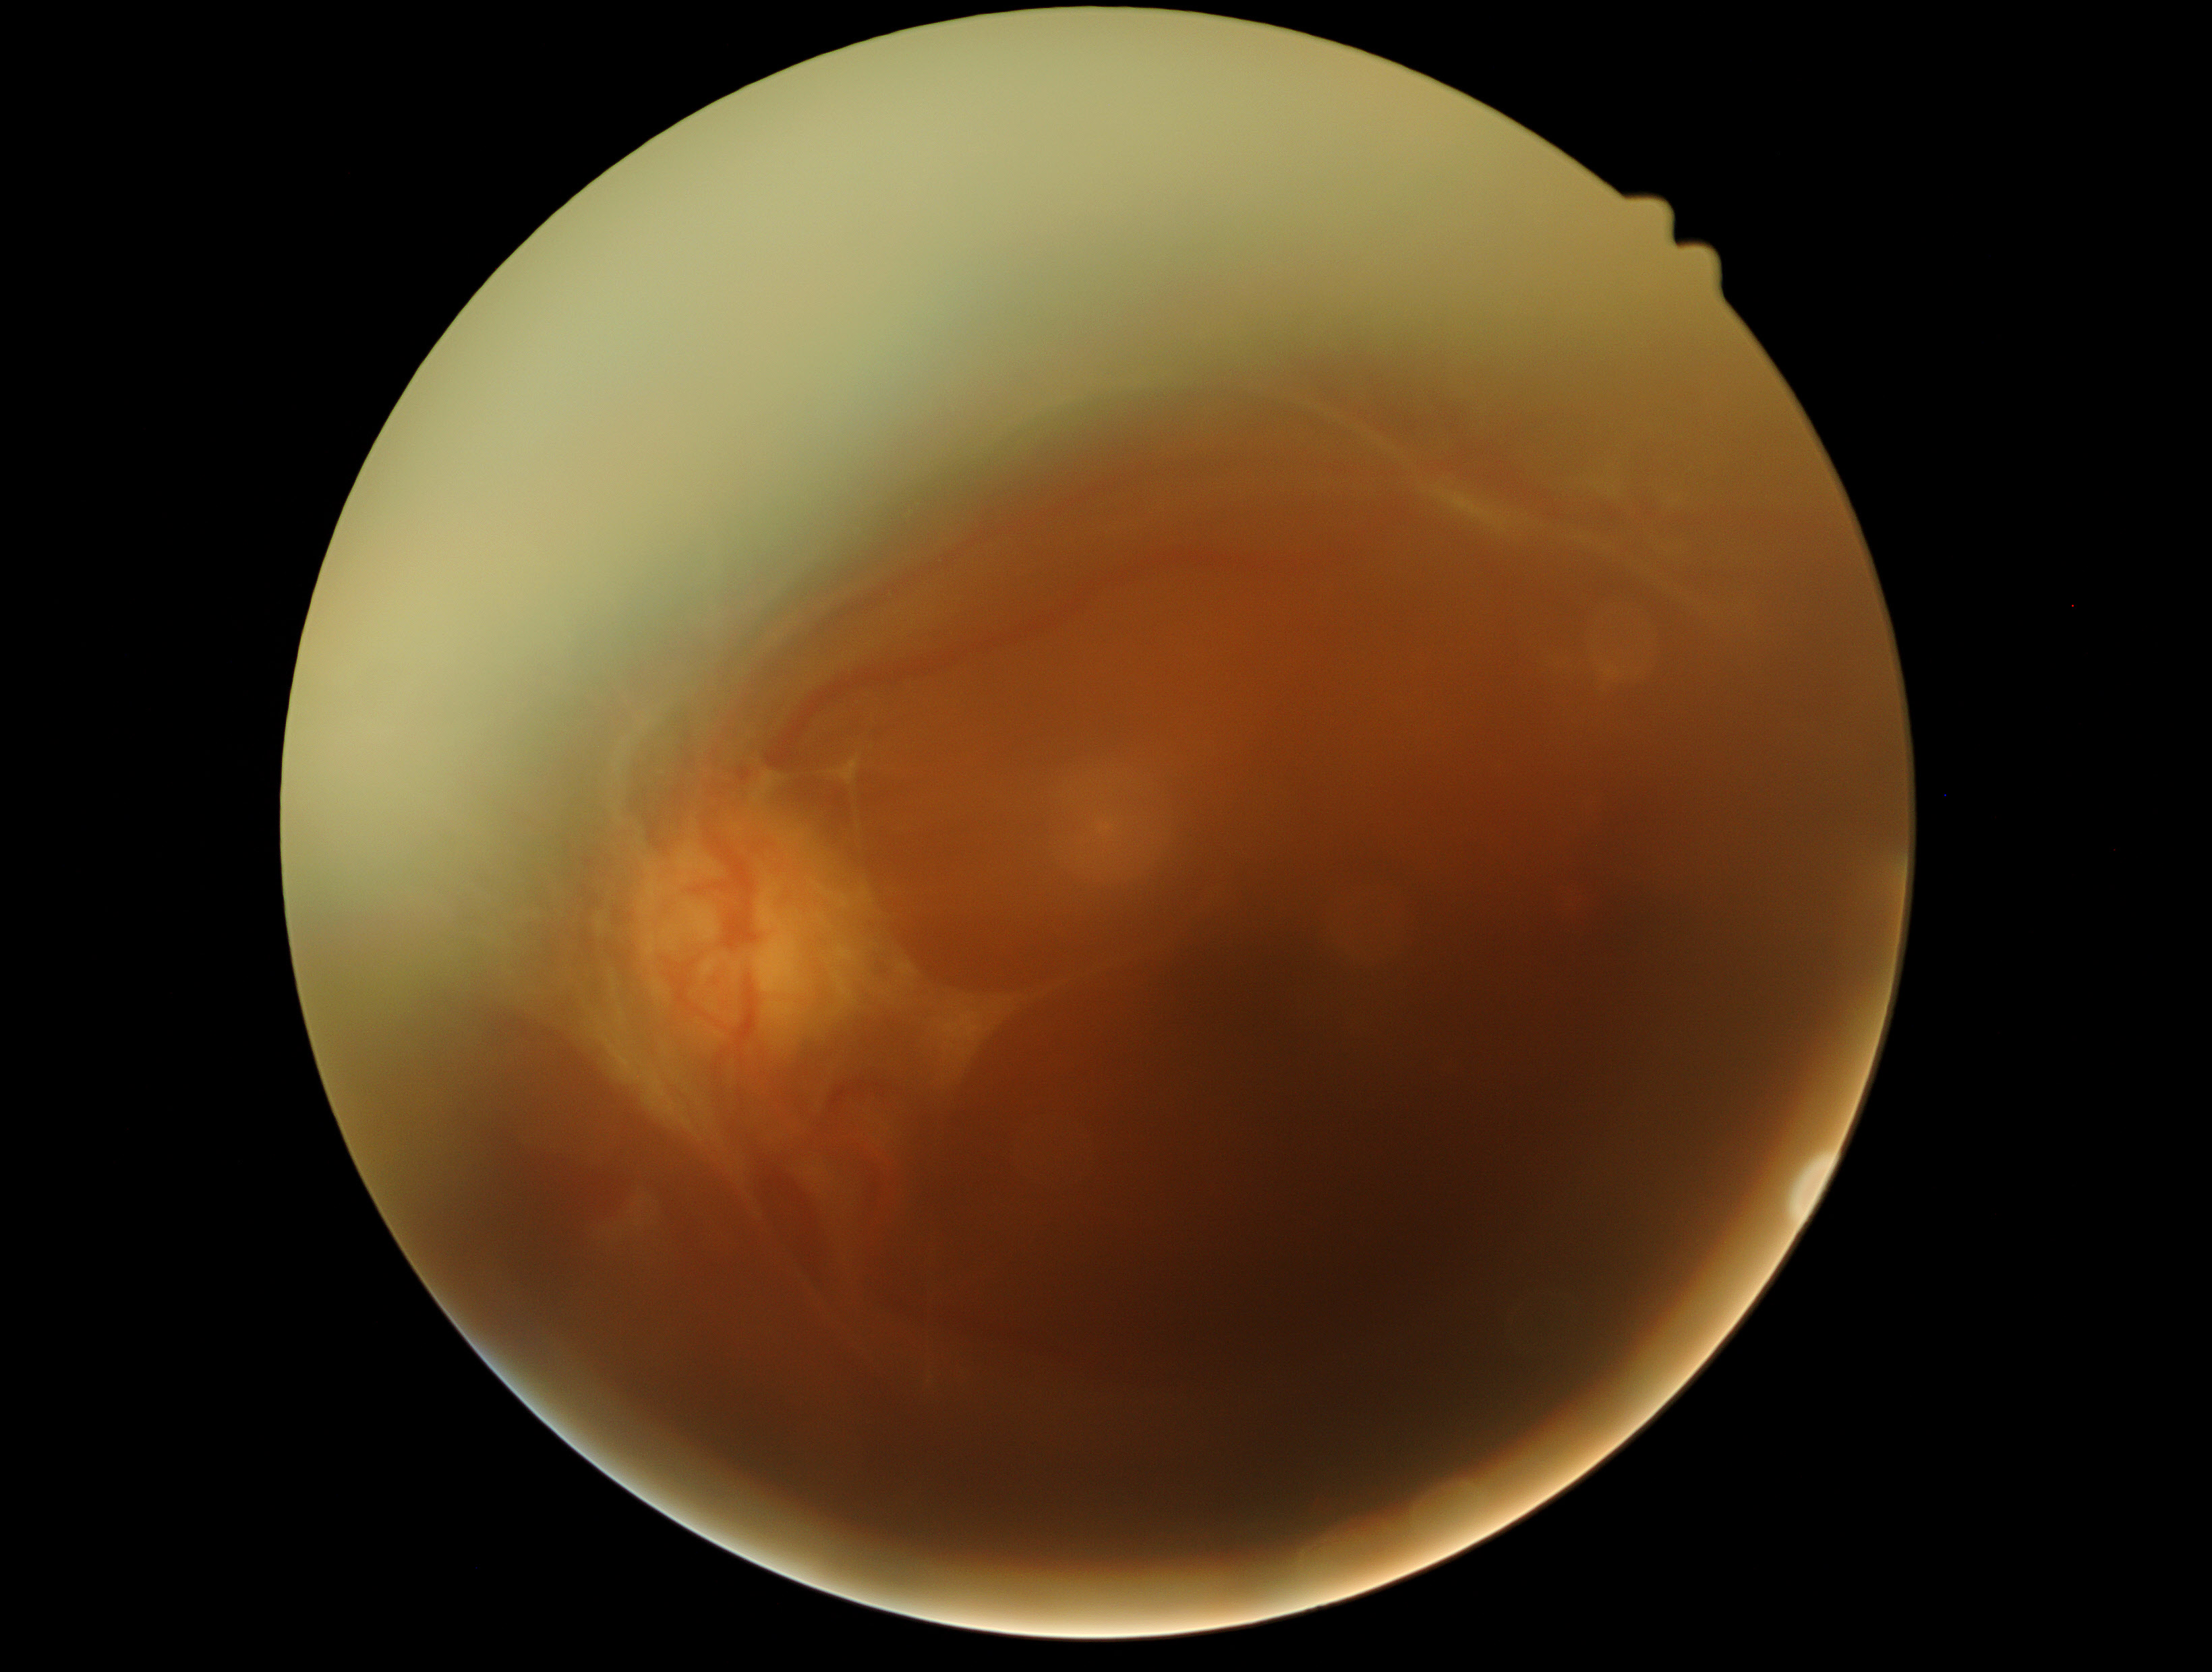 diabetic retinopathy severity: grade 4 (PDR) — neovascularization and/or vitreous/pre-retinal hemorrhage.